200° FOV; UWF retinal mosaic
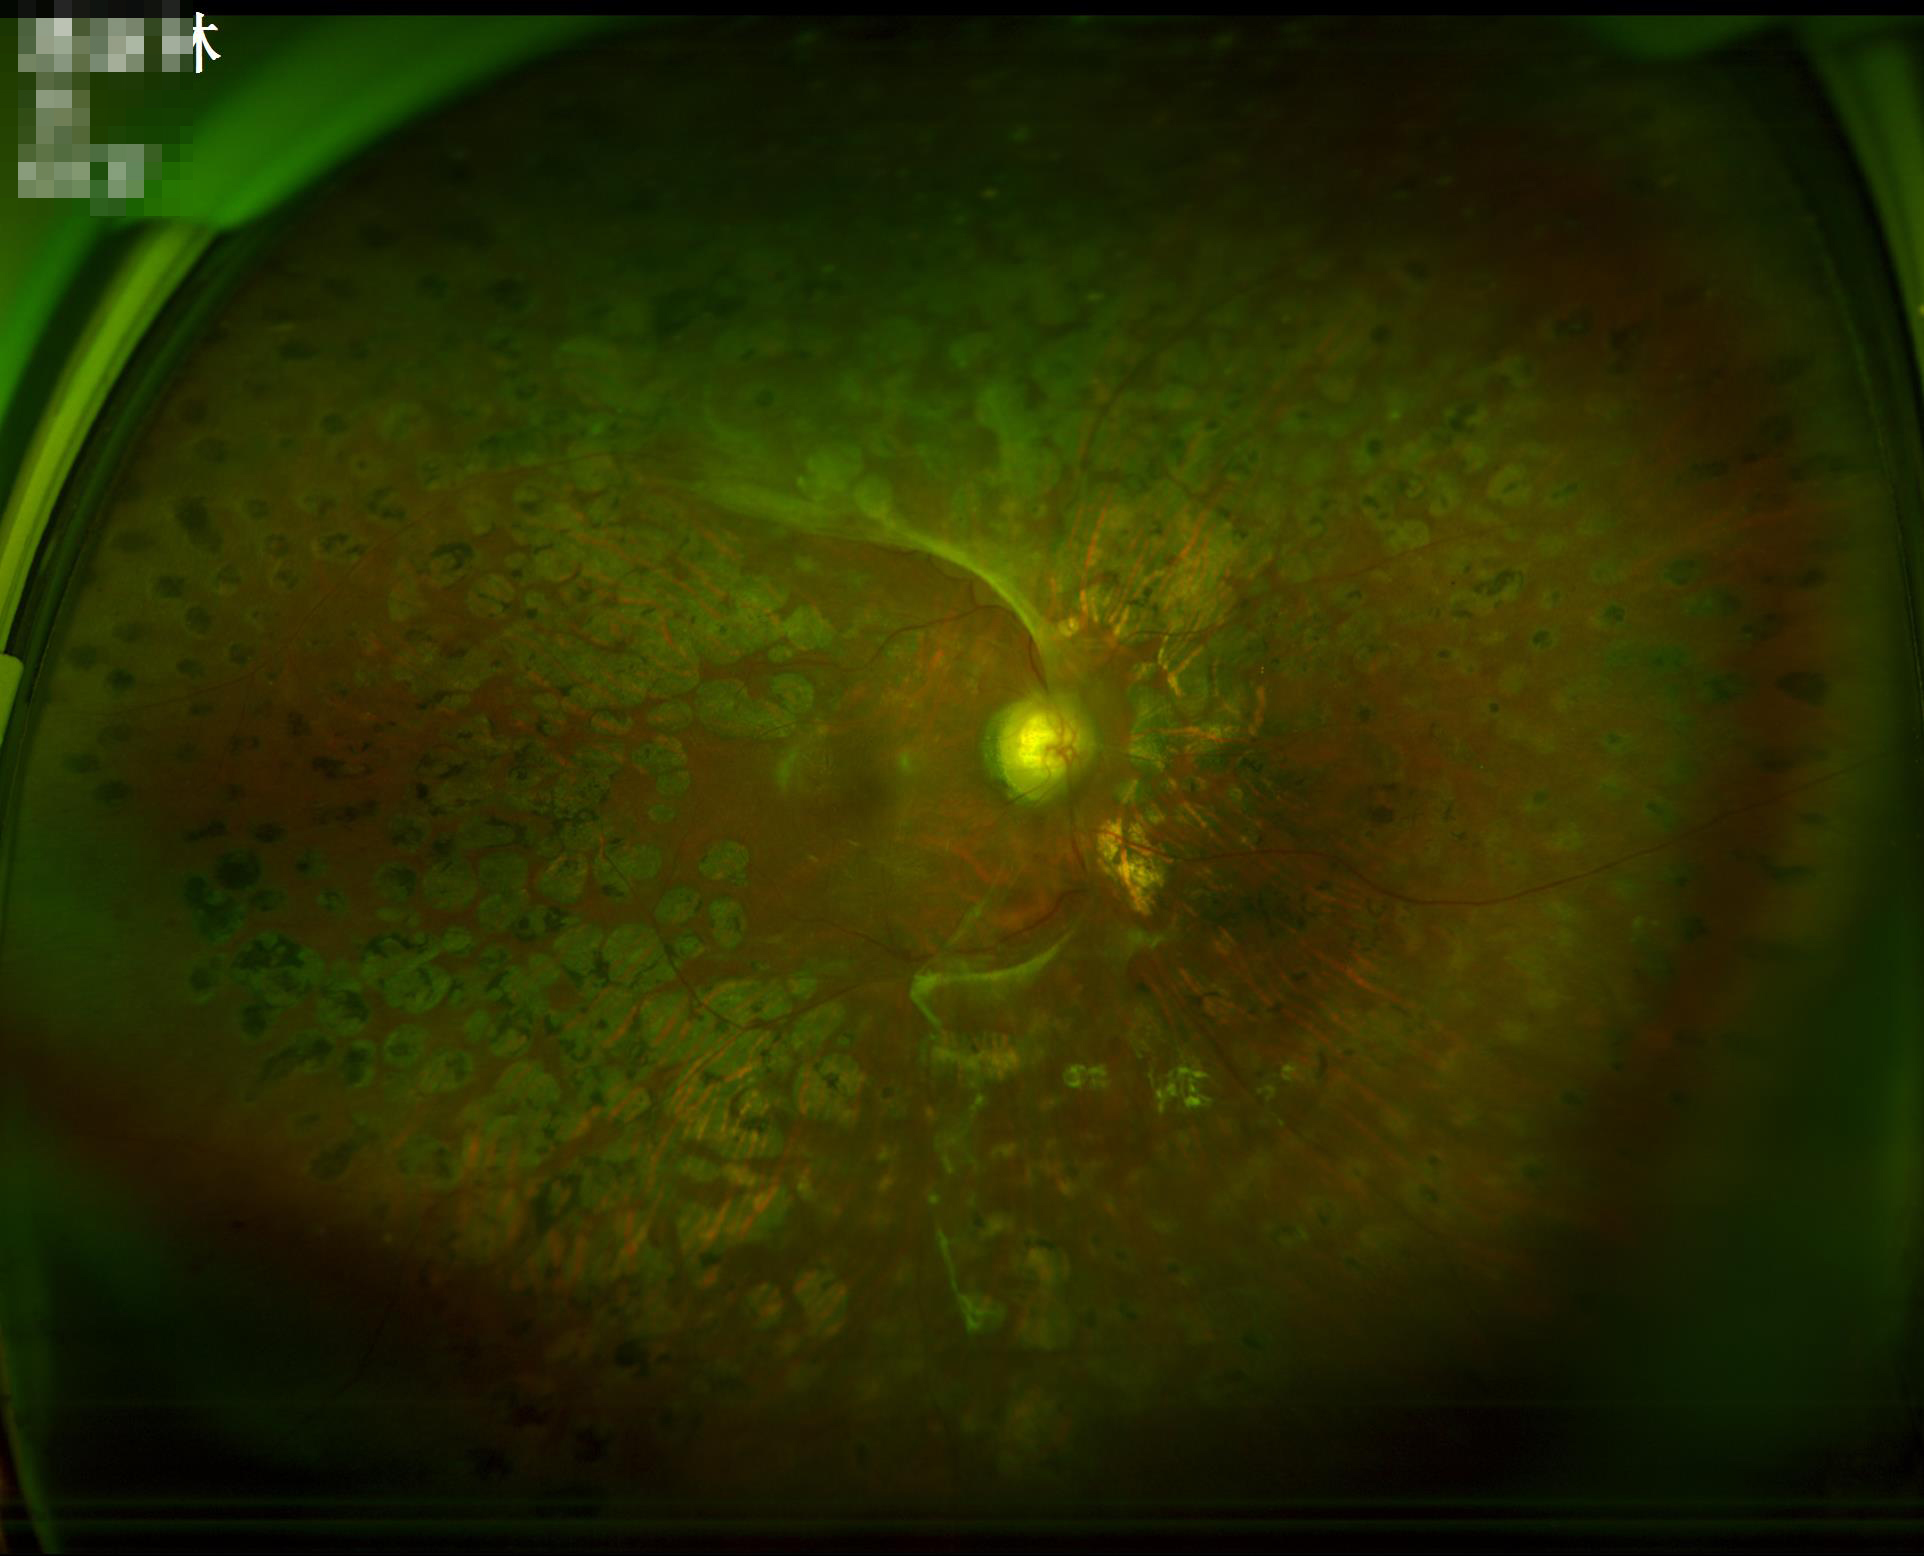 Clarity: good; Contrast: reduced; Overall quality: poor.